1380 x 1382 pixels, color fundus image: 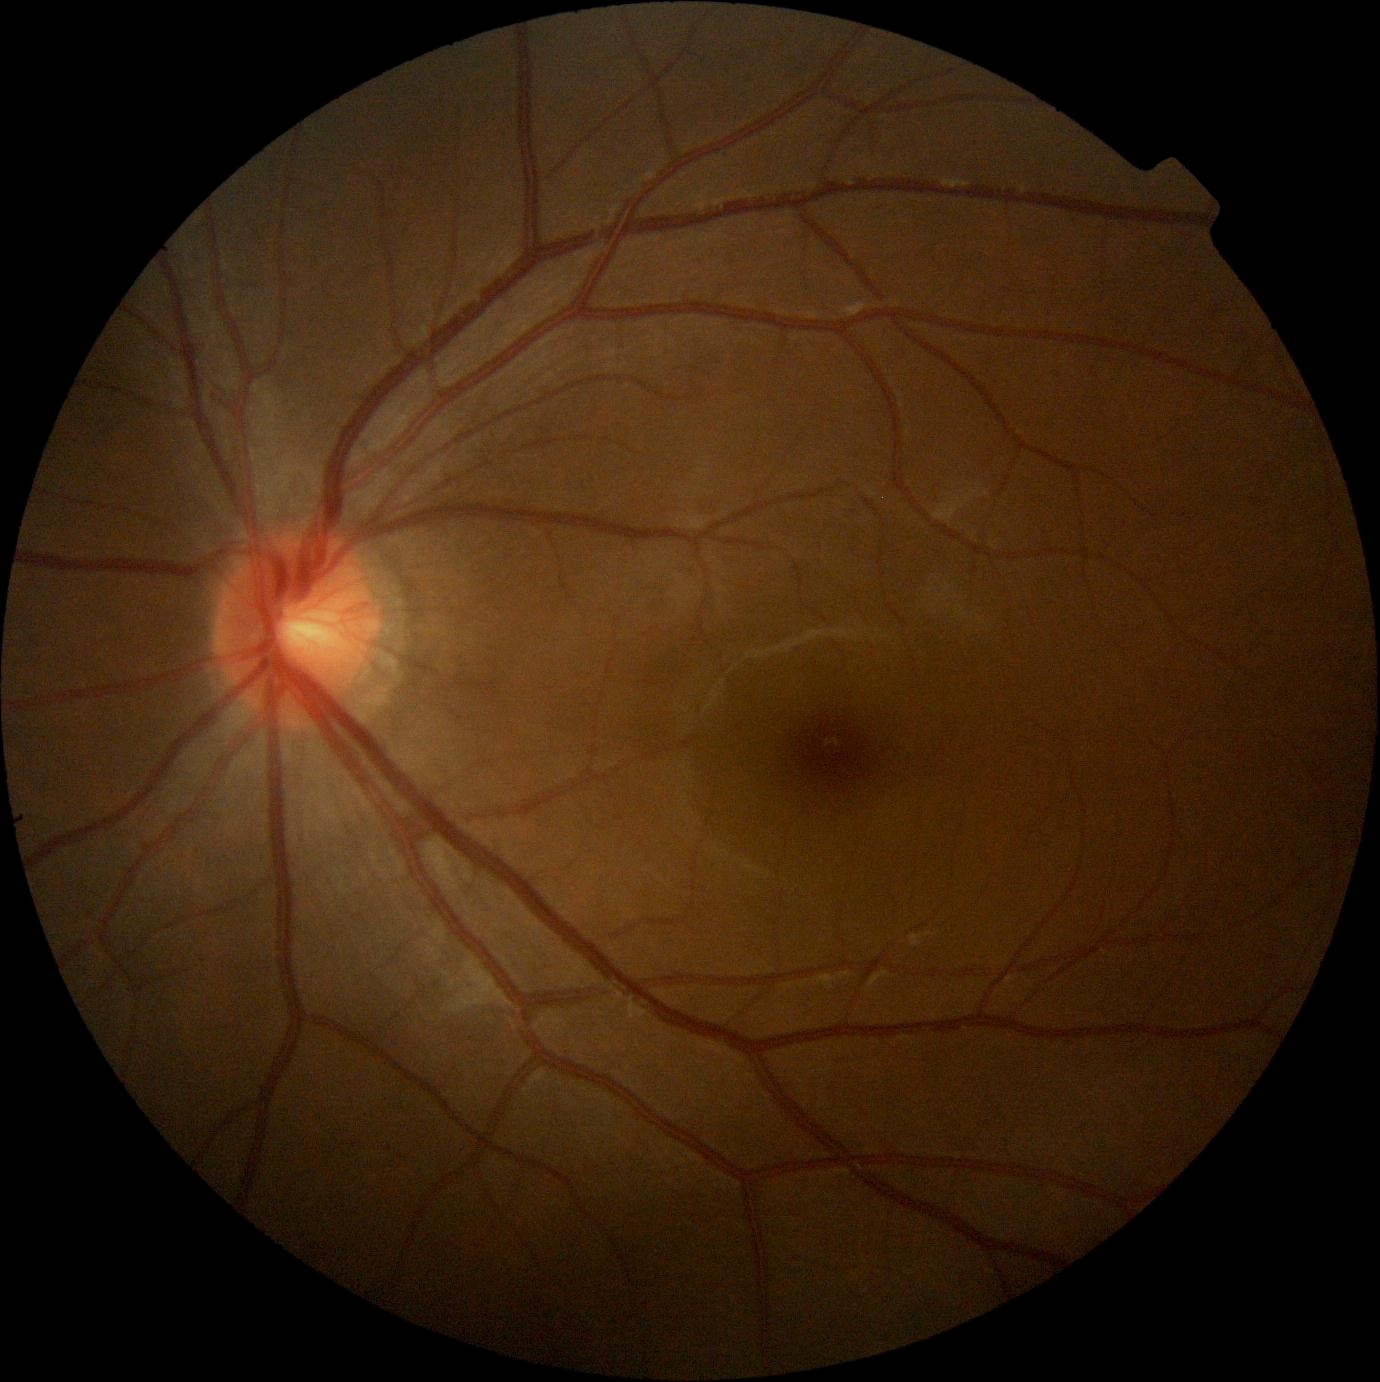 DR is 0/4.